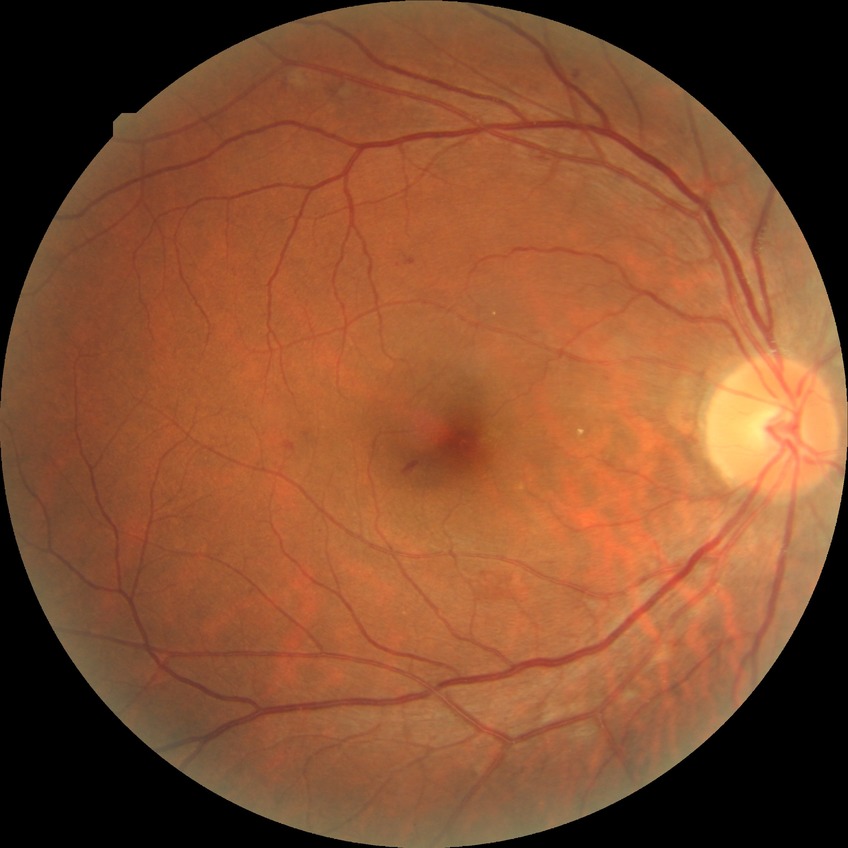
The retinopathy is classified as non-proliferative diabetic retinopathy.
Diabetic retinopathy grade is simple diabetic retinopathy.